Wide-field fundus image from infant ROP screening:
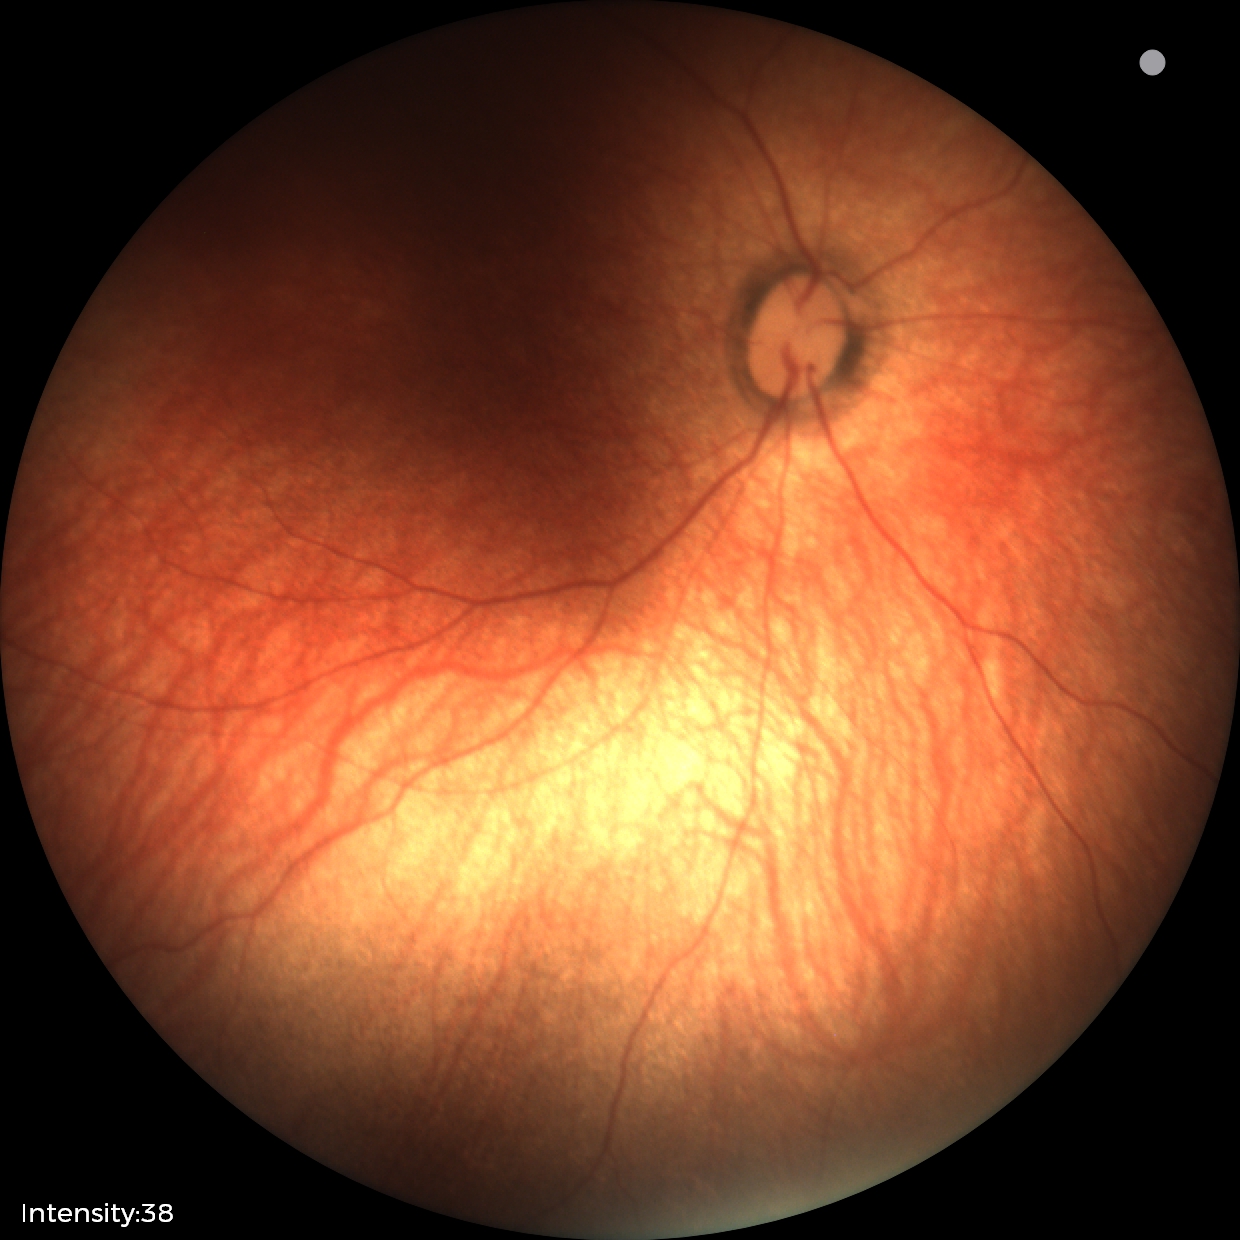 Examination with physiological retinal findings.